Wide-field fundus photograph from neonatal ROP screening · 100° field of view (Phoenix ICON): 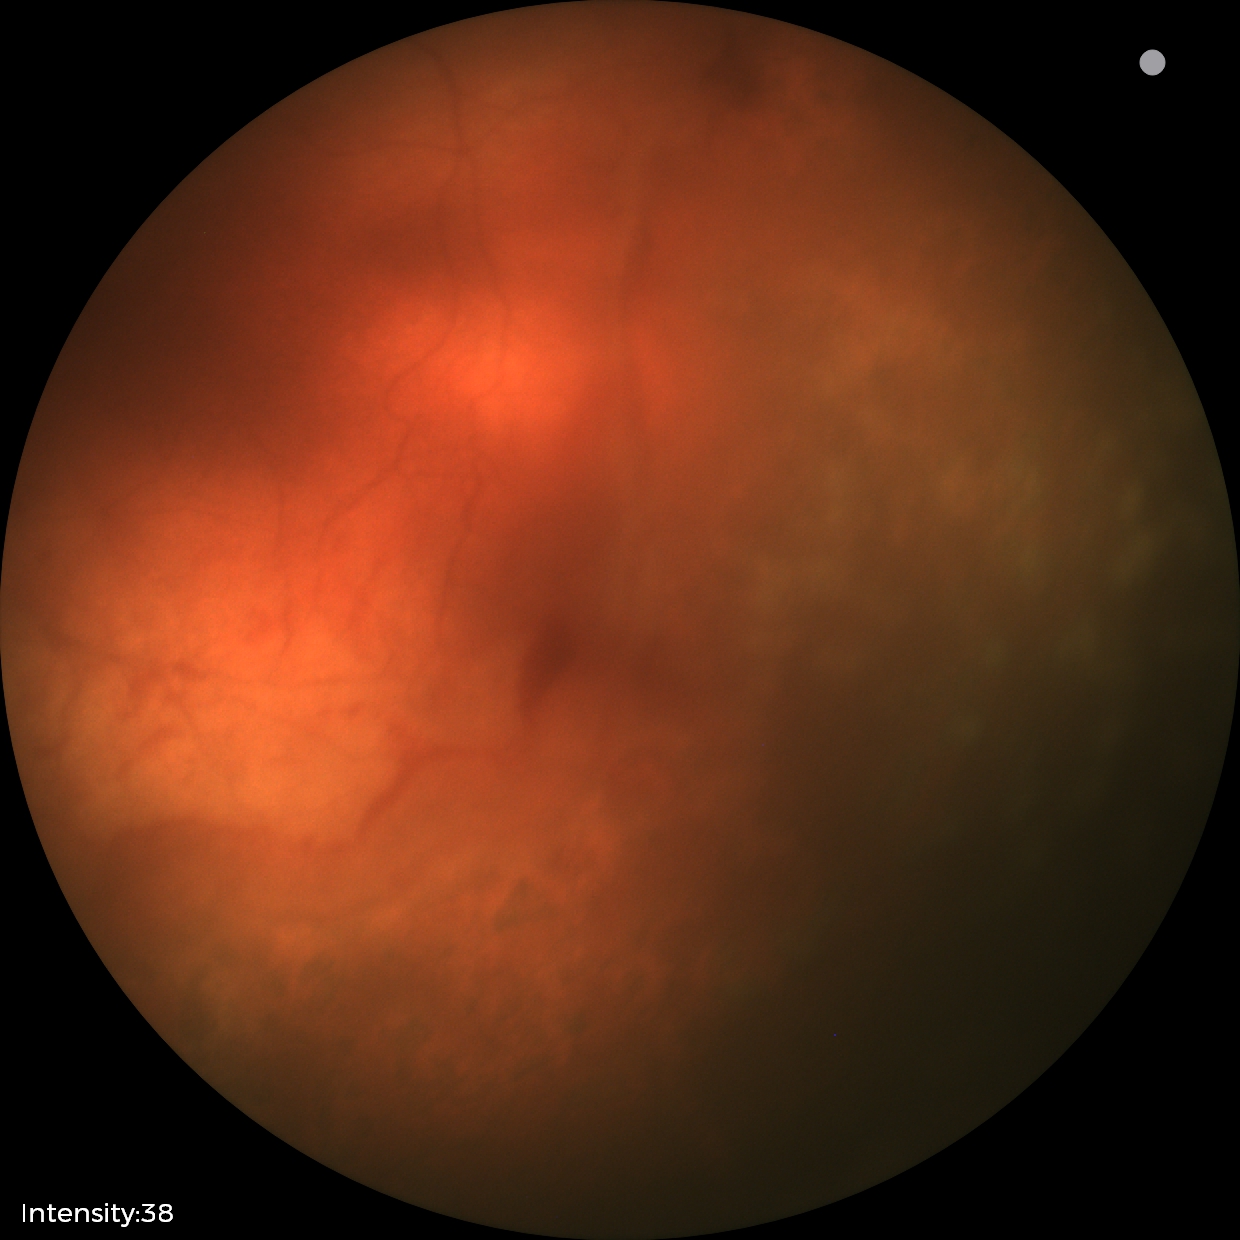
Assessment: status post retinopathy of prematurity (ROP) — retinal appearance after treated retinopathy of prematurity, plus disease: absent.